Captured with the Phoenix ICON (100° field of view) · pediatric wide-field fundus photograph: 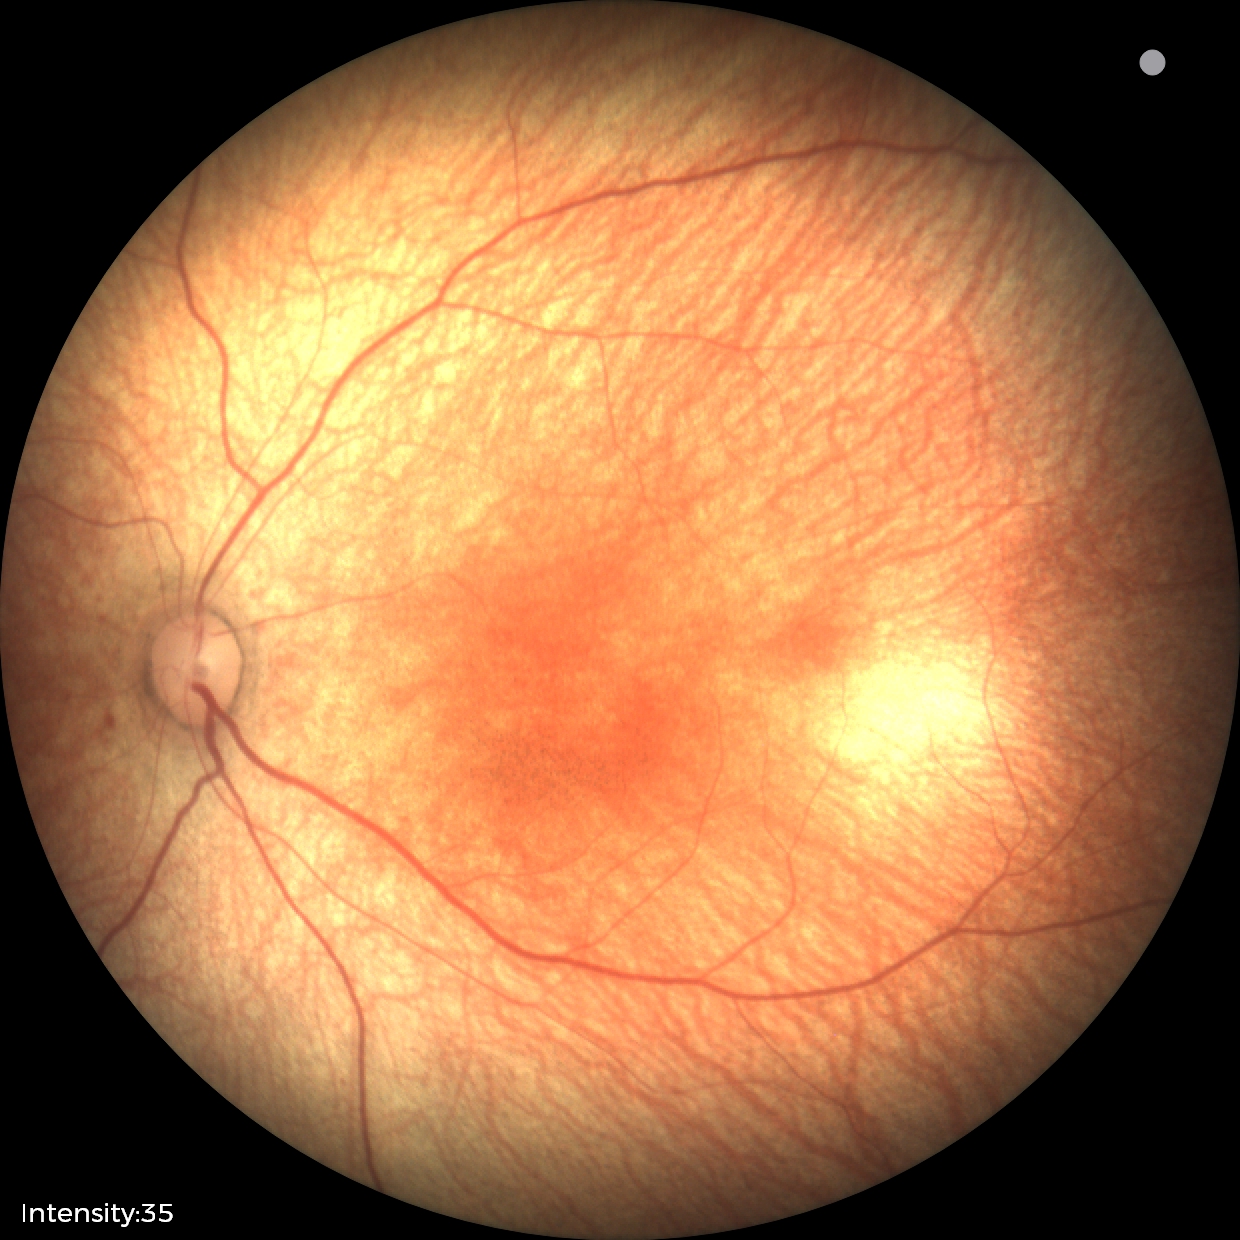
Screening examination with no abnormal retinal findings.